100° field of view (Phoenix ICON). Phoenix ICON wide-field infant fundus image
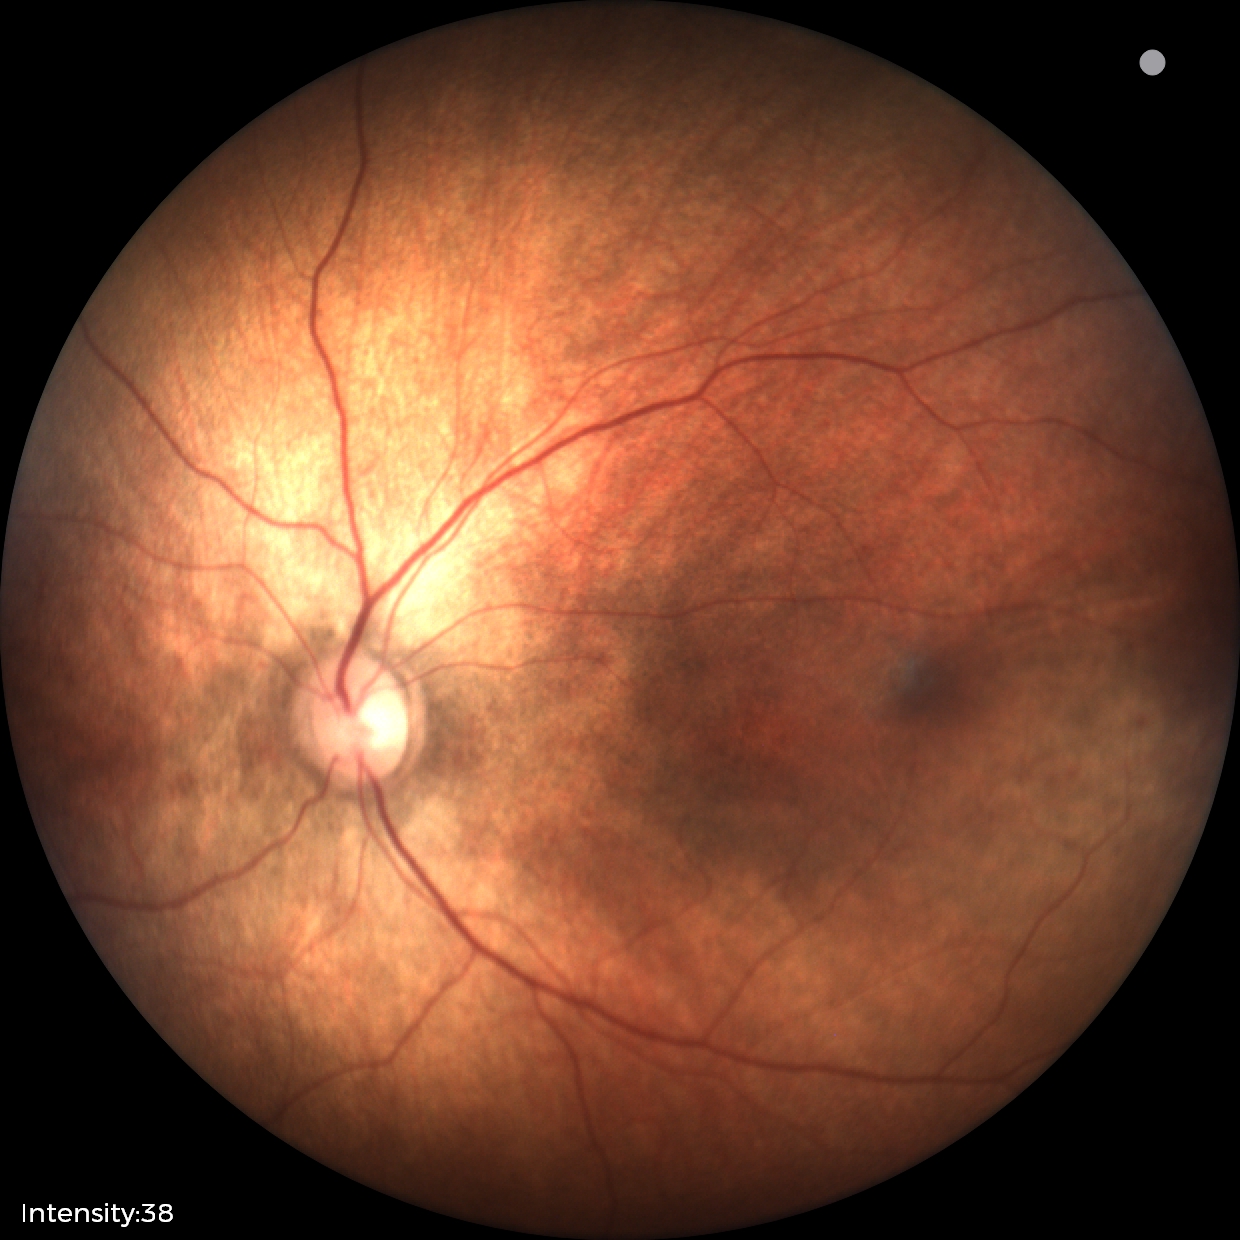

Screening: physiological retinal finding.